Pediatric wide-field fundus photograph. 1240x1240 — 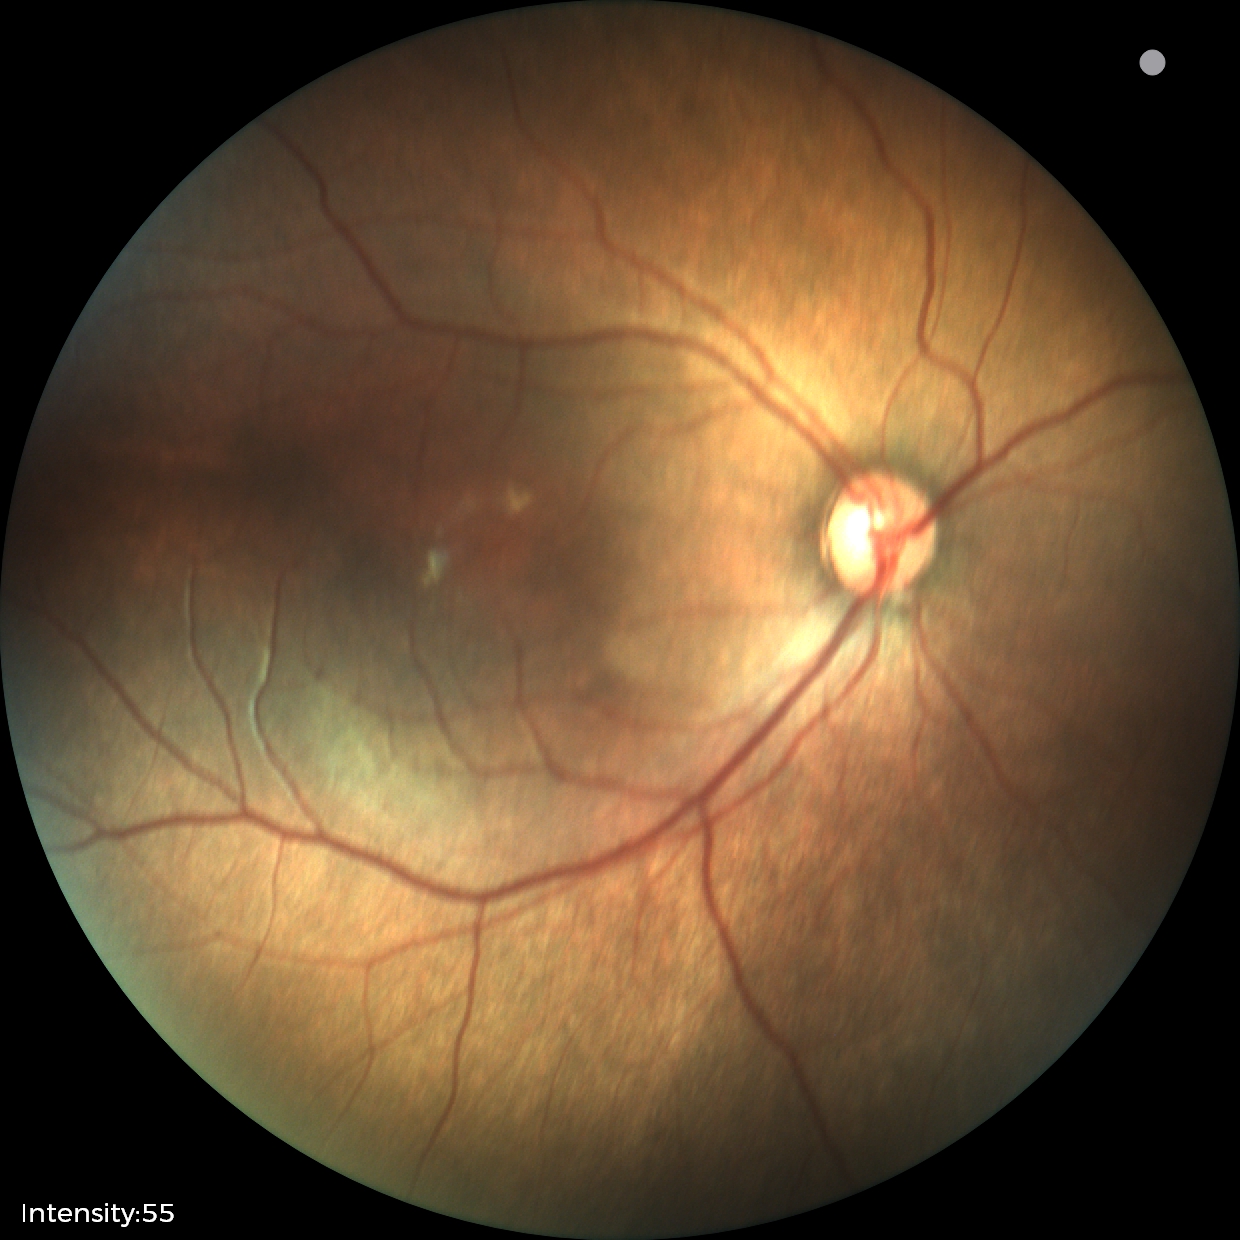

Assessment: status post ROP; no plus disease — posterior pole vessels without abnormal dilation or tortuosity.